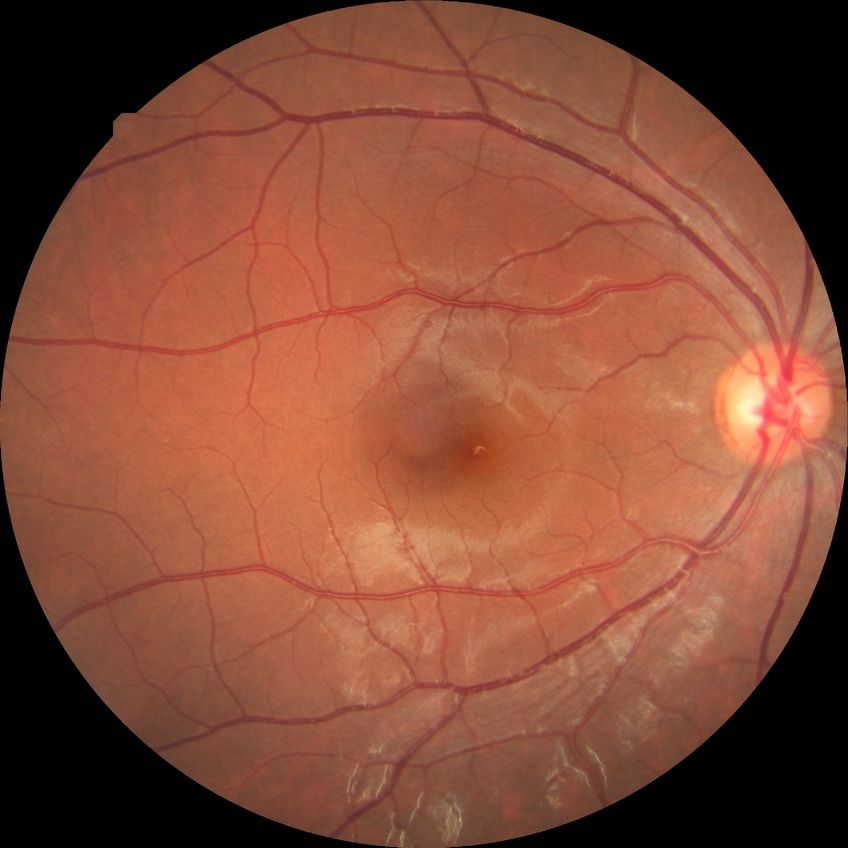
diabetic retinopathy (DR): NDR (no diabetic retinopathy).